Retinal fundus photograph, FOV: 45 degrees.
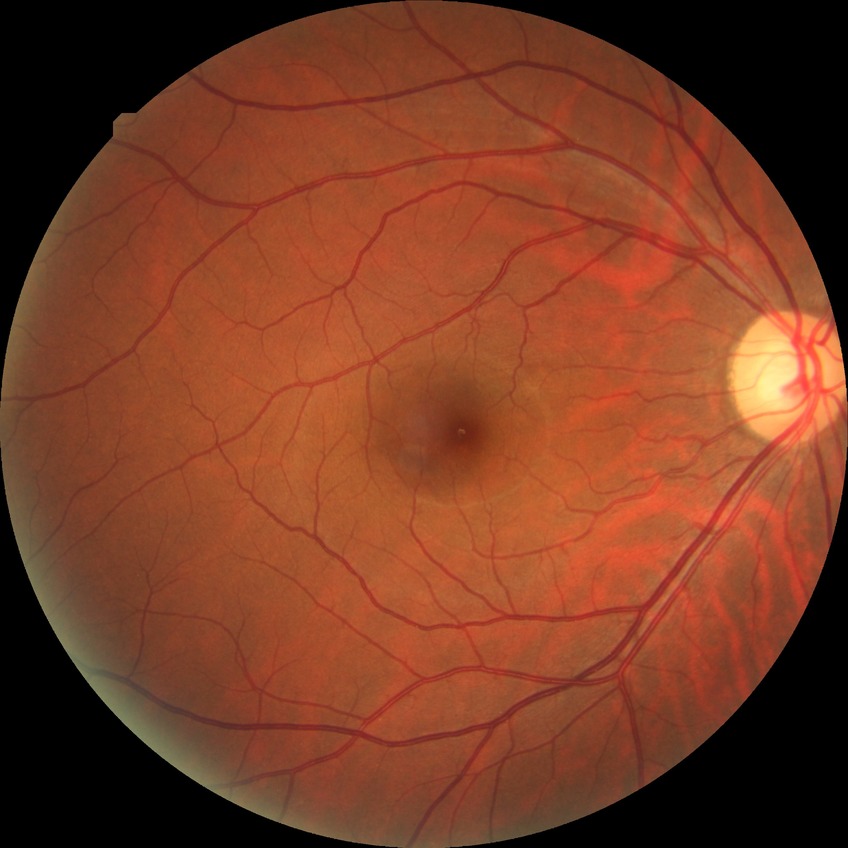
Diabetic retinopathy (DR) is no diabetic retinopathy (NDR).